45° FOV. Nonmydriatic — 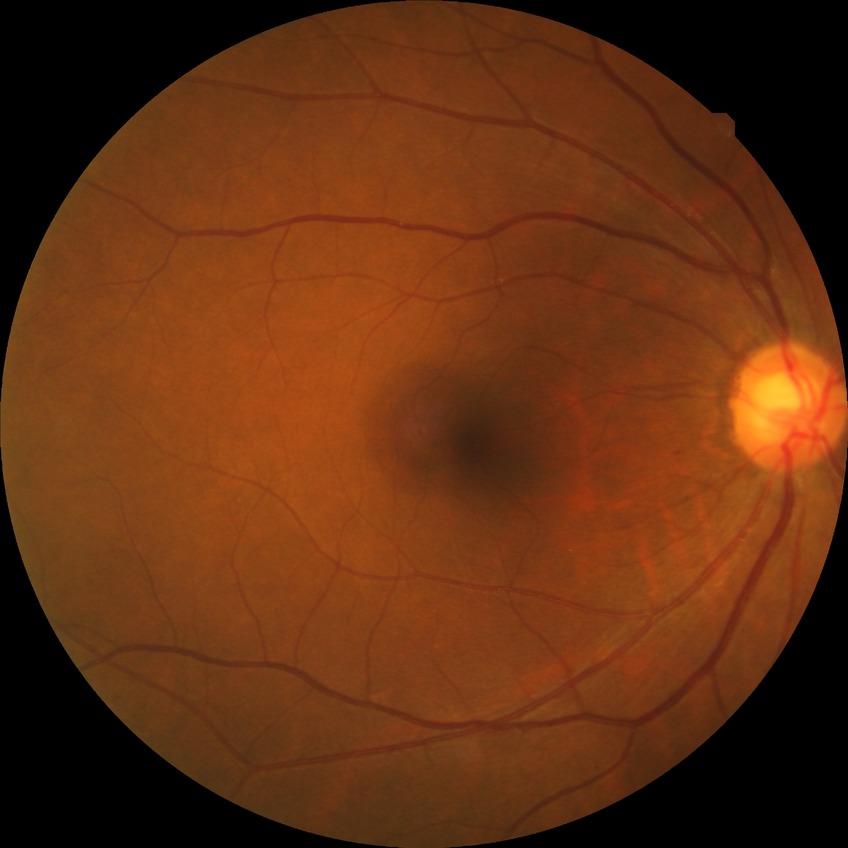 Diabetic retinopathy severity is simple diabetic retinopathy.